Wide-field fundus photograph of an infant
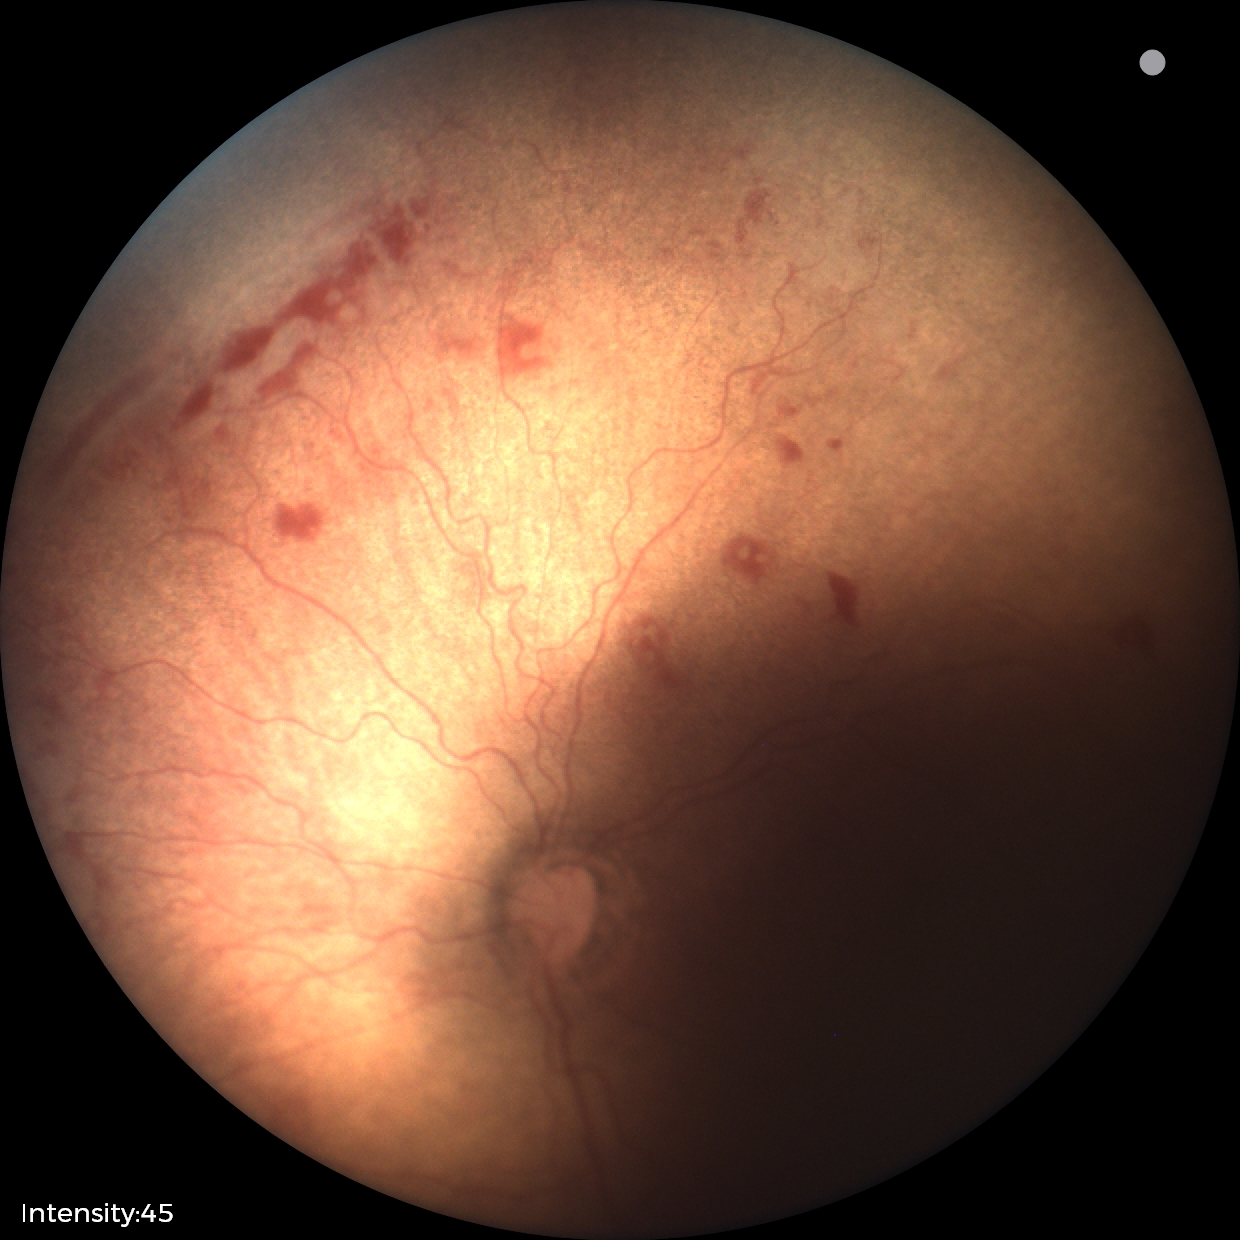
Screening diagnosis = retinopathy of prematurity (ROP) stage 1 — demarcation line between vascular and avascular retina | plus form = absent.